60° field of view
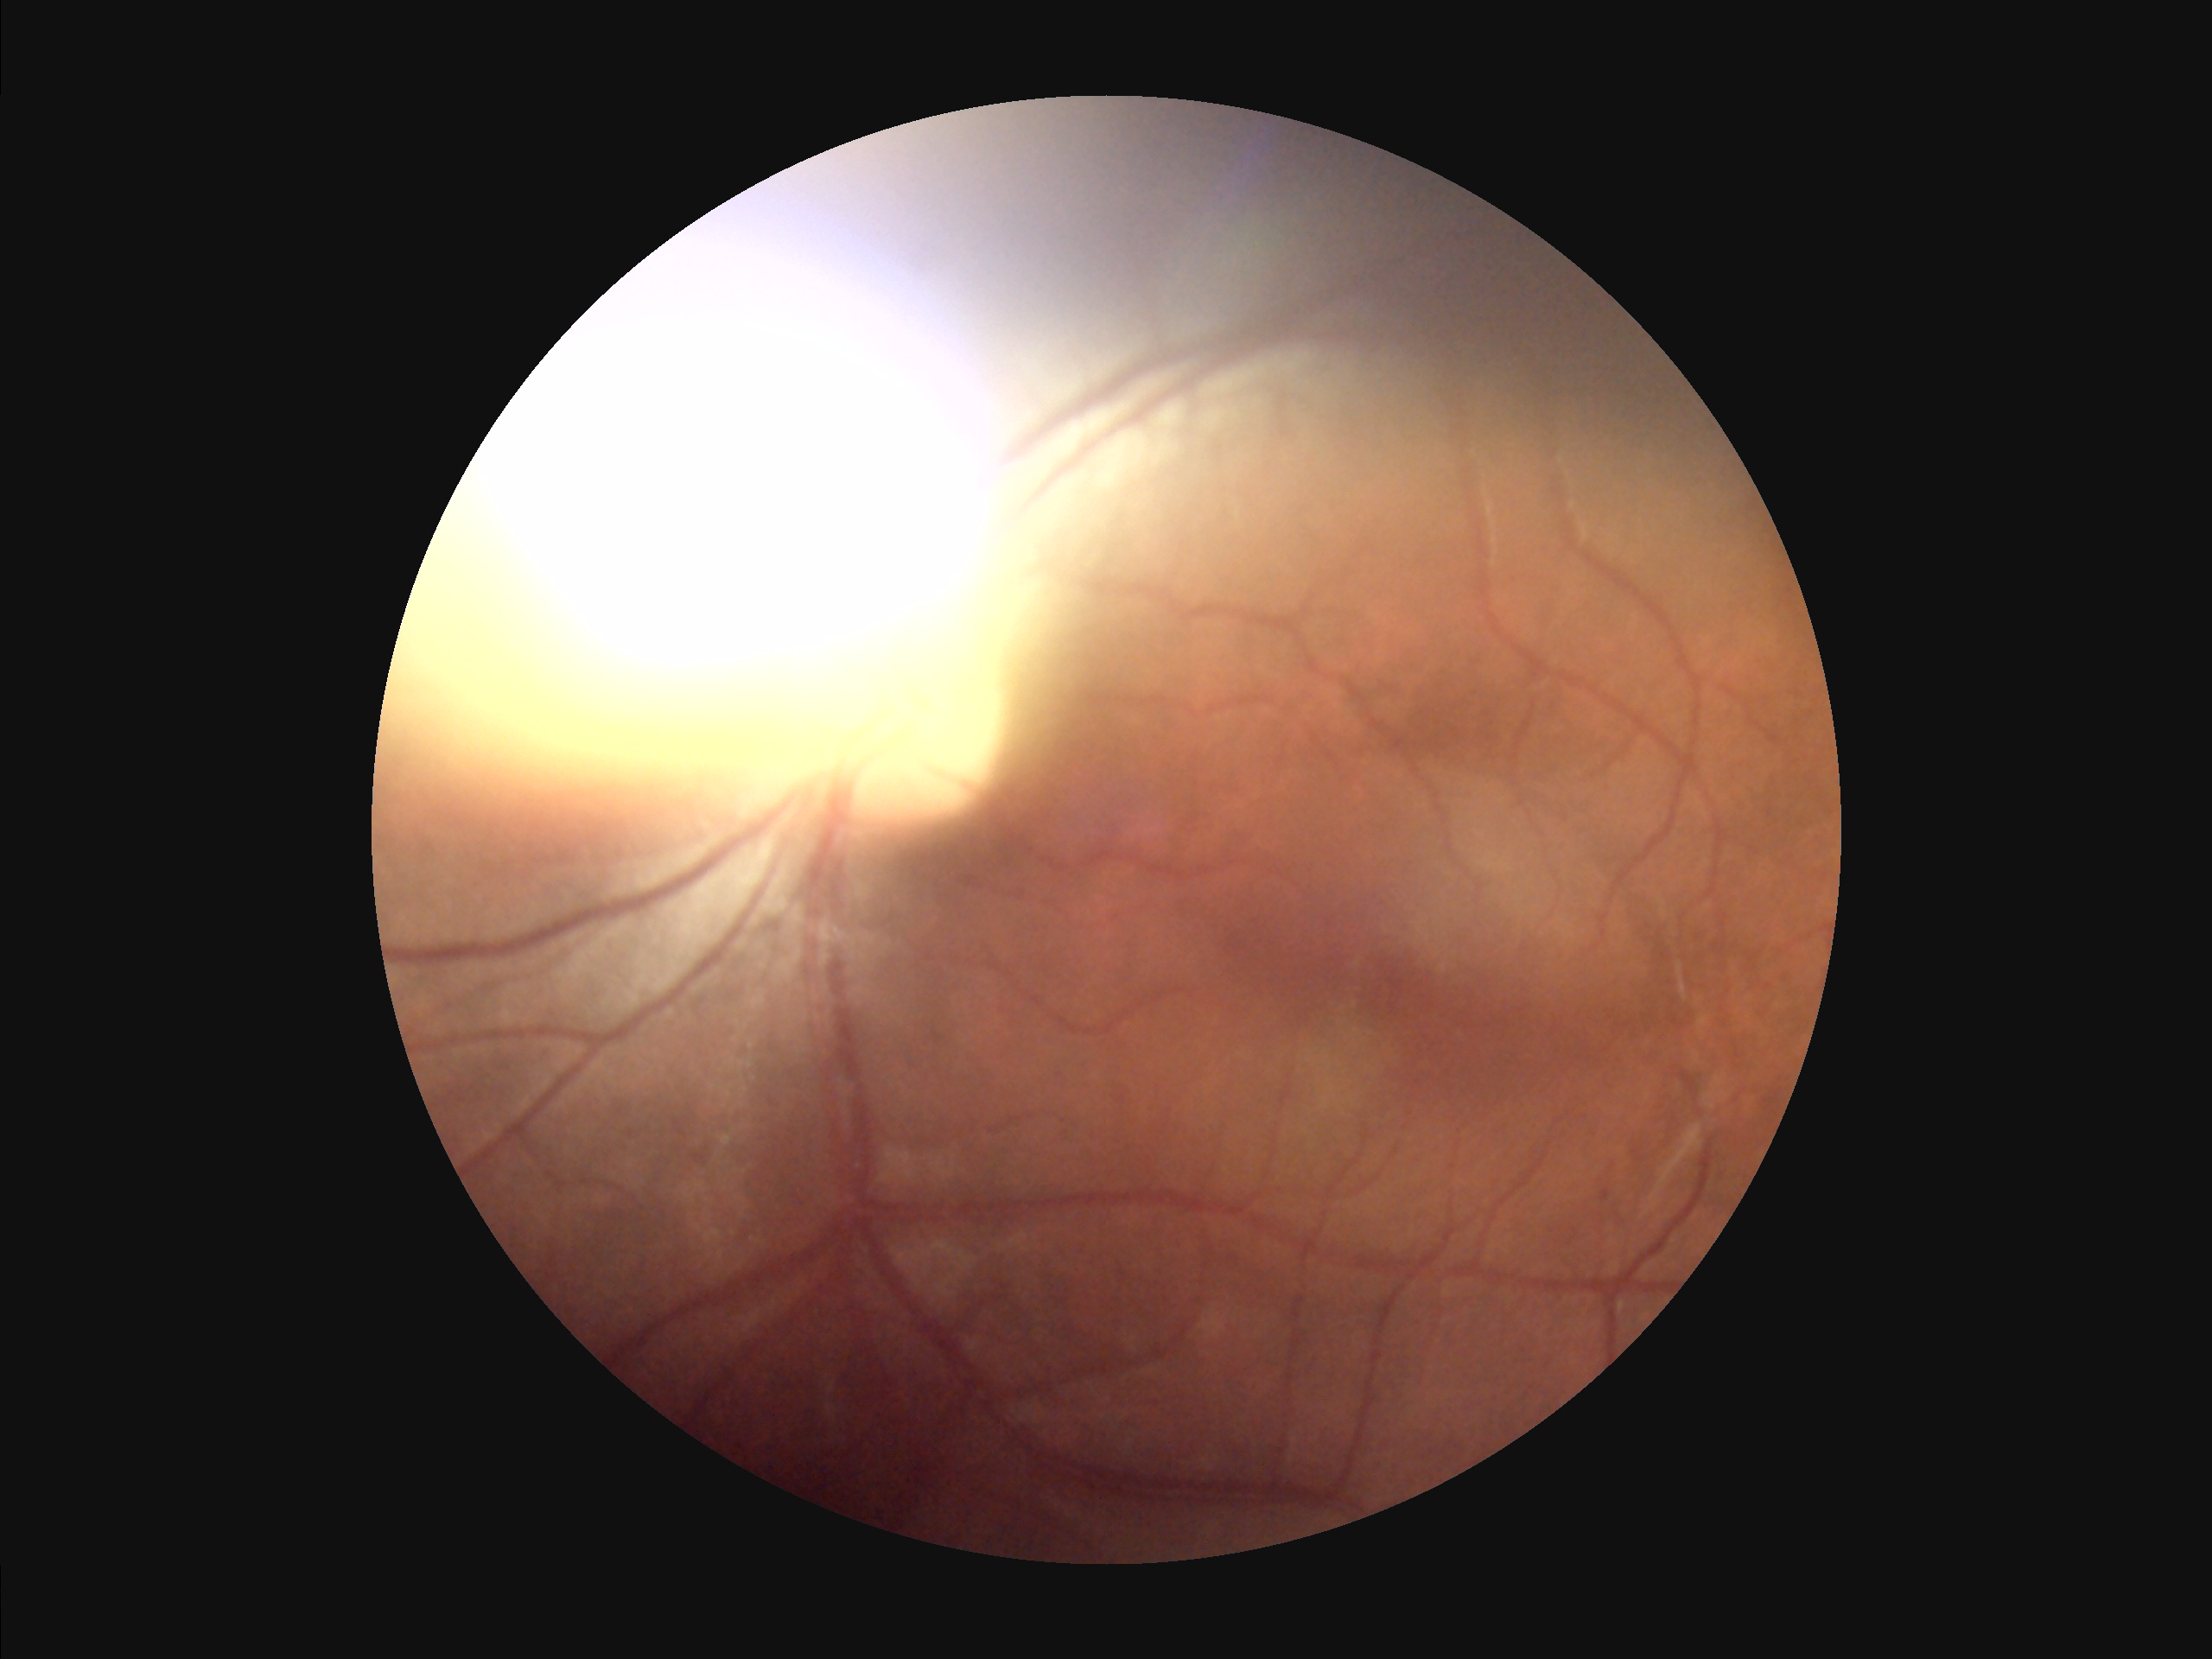
Image quality:
- contrast: reduced
- illumination/color: suboptimal
- overall: suboptimal
- sharpness: blurry